Acquired with a NIDEK AFC-230; nonmydriatic fundus photograph.
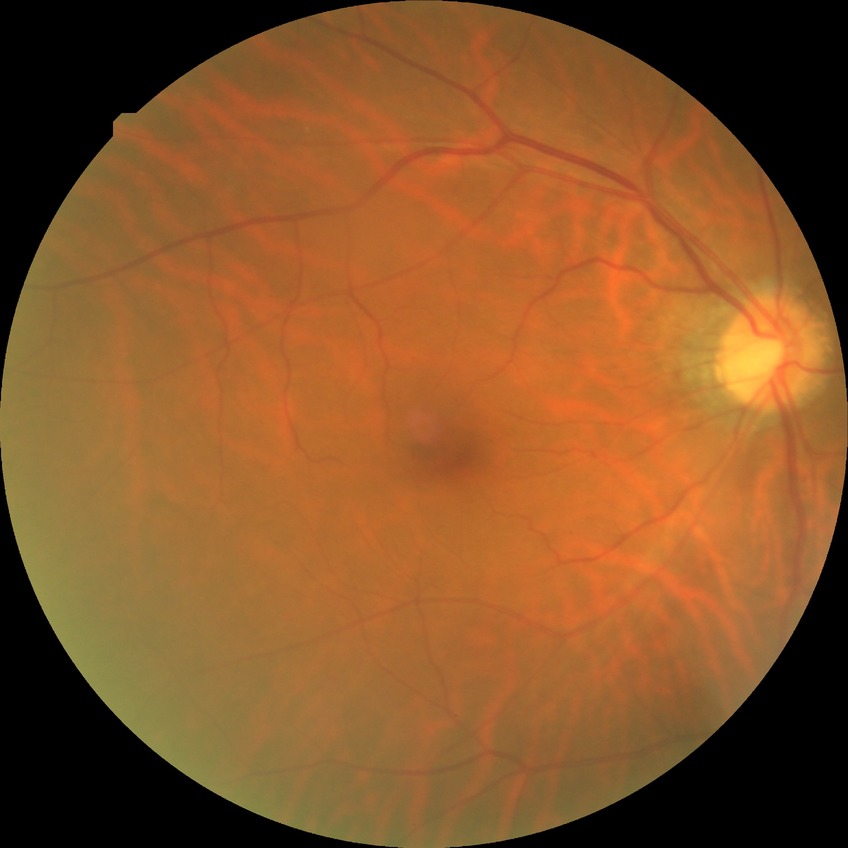 davis_grade: no diabetic retinopathy